45-degree field of view; color fundus image.
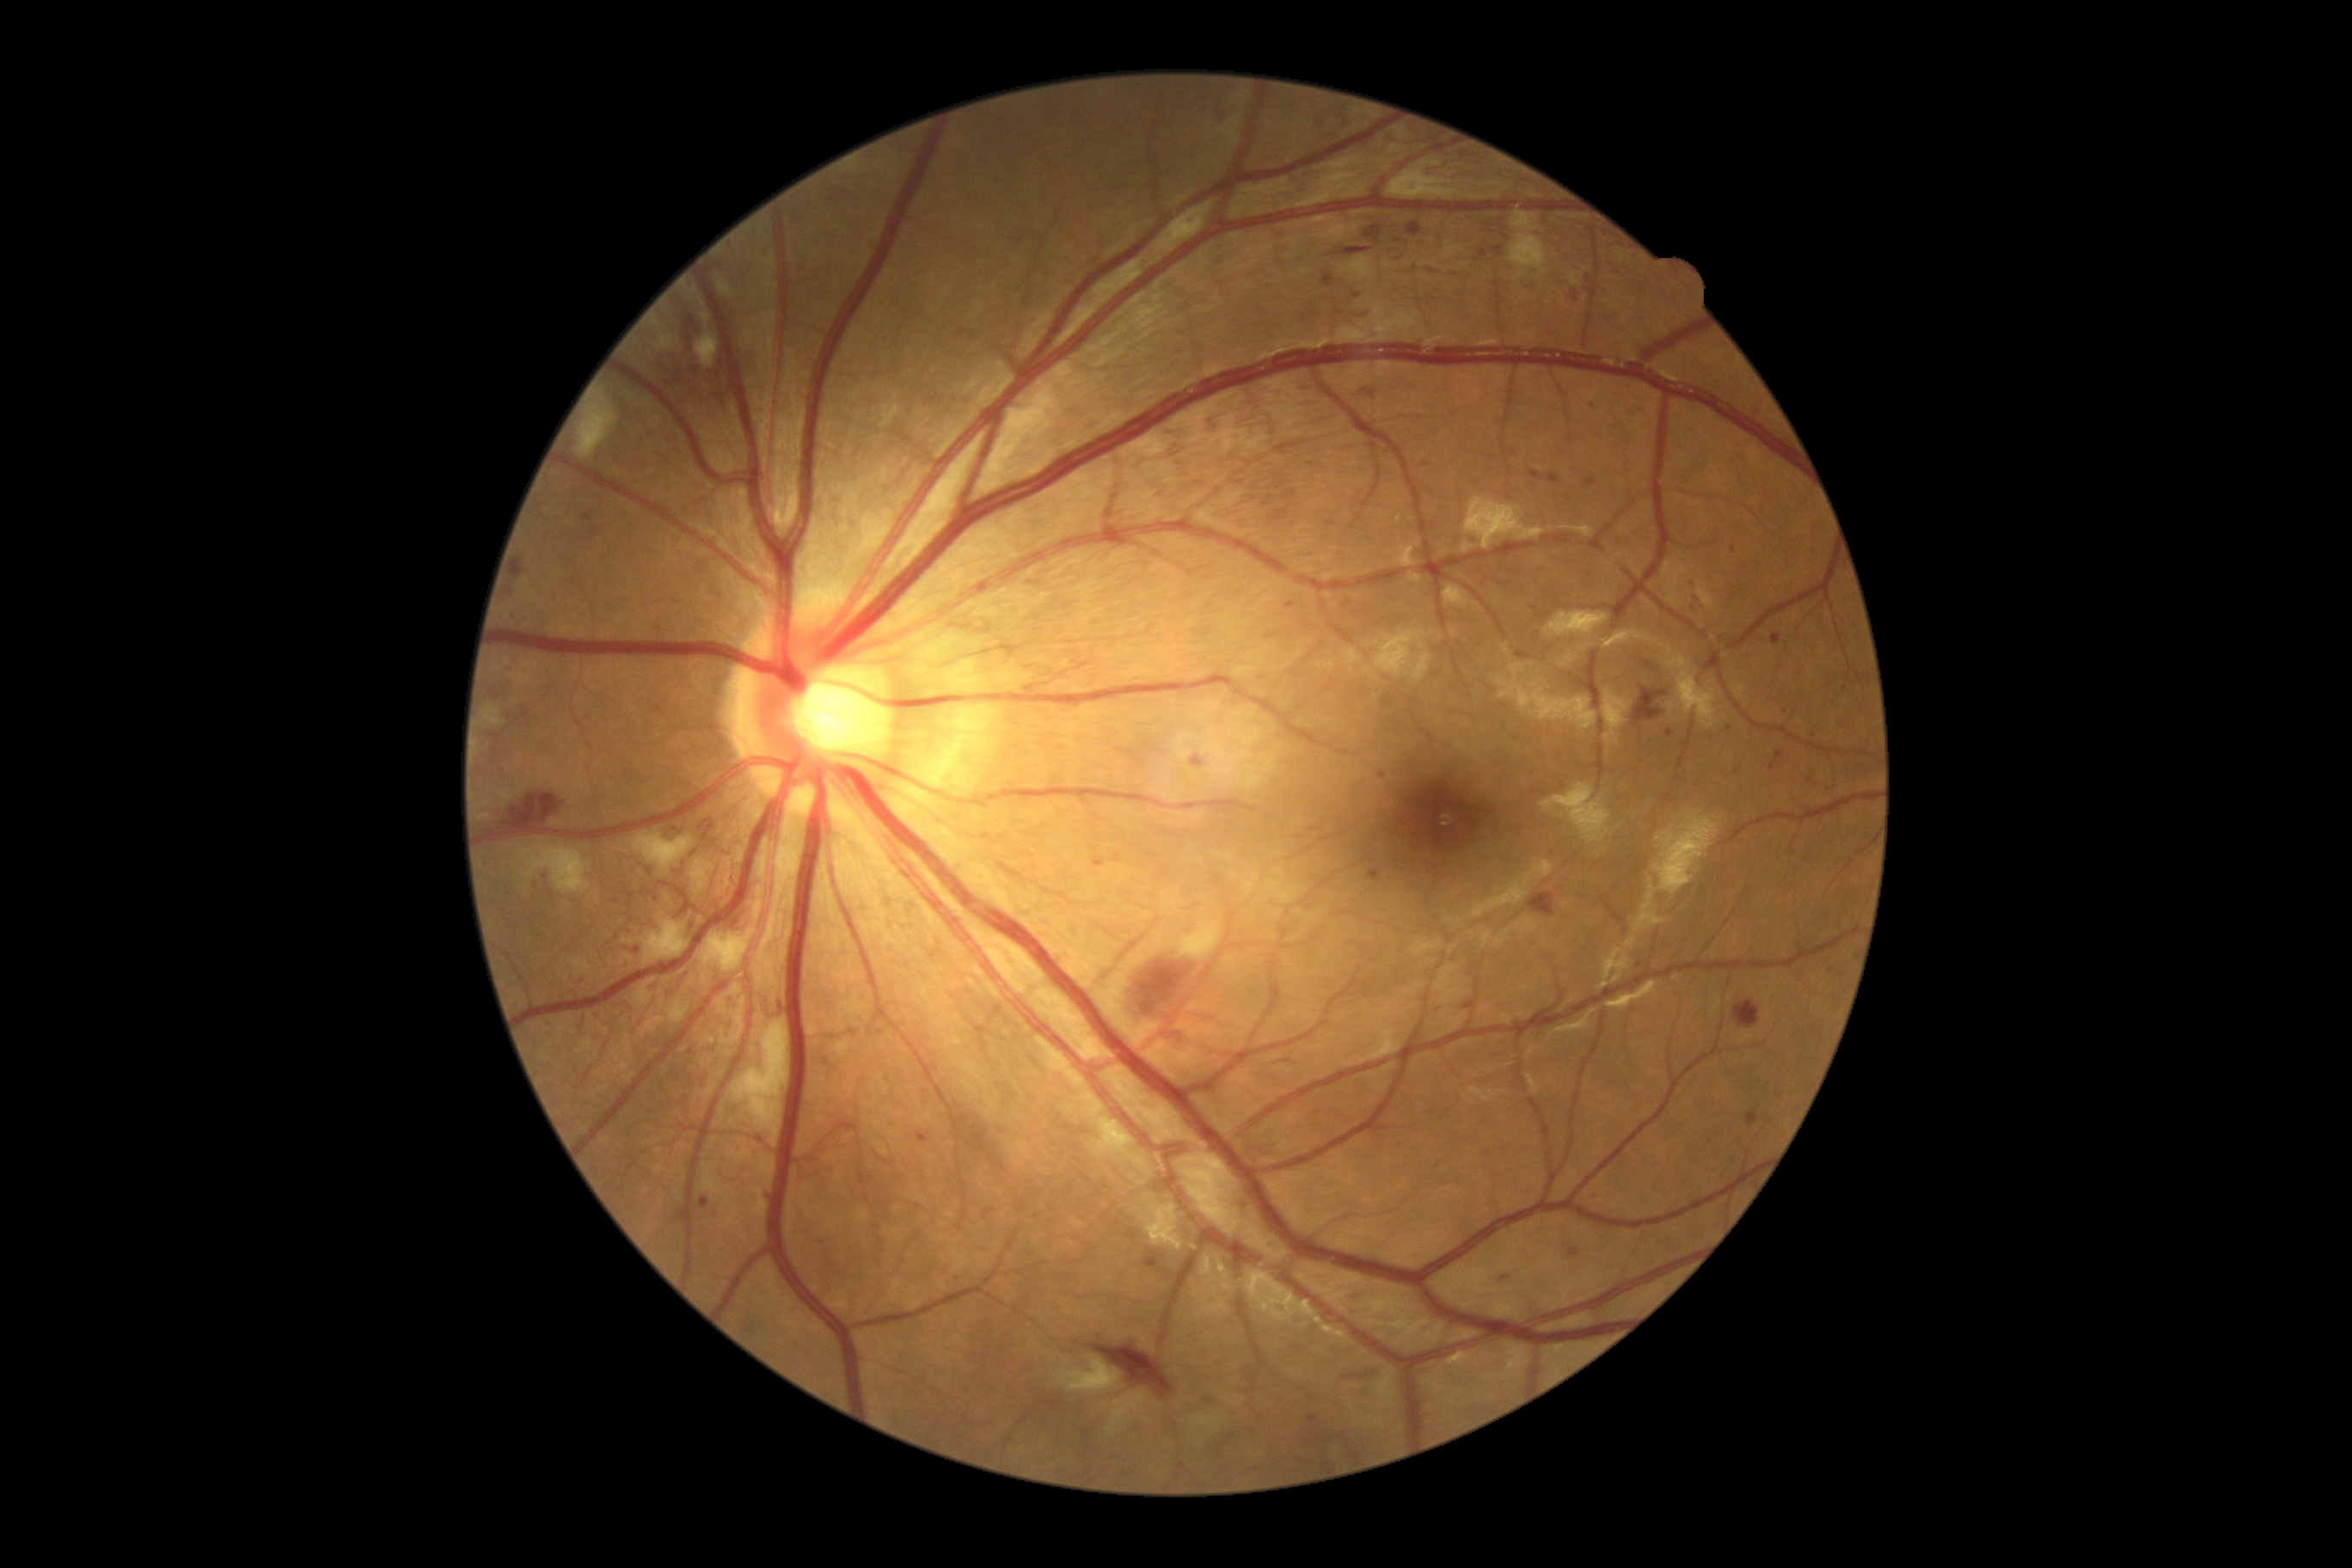 Diabetic retinopathy (DR): severe non-proliferative diabetic retinopathy (grade 3)
Selected lesions:
* hemorrhages (HEs) (subset): x1=1366, y1=333, x2=1381, y2=341; x1=1344, y1=248, x2=1373, y2=257; x1=1772, y1=635, x2=1780, y2=646; x1=1156, y1=491, x2=1168, y2=499; x1=733, y1=919, x2=740, y2=928; x1=1632, y1=687, x2=1667, y2=725; x1=979, y1=1242, x2=995, y2=1254; x1=1265, y1=496, x2=1273, y2=506; x1=1675, y1=946, x2=1689, y2=959; x1=1185, y1=216, x2=1199, y2=224; x1=1526, y1=283, x2=1540, y2=298; x1=1311, y1=415, x2=1338, y2=426; x1=1612, y1=422, x2=1634, y2=450; x1=1528, y1=469, x2=1543, y2=481
* Smaller HEs around <point>656, 899</point>; <point>1424, 465</point>; <point>1534, 608</point>; <point>1738, 772</point>; <point>782, 1008</point>